Fundus photo: 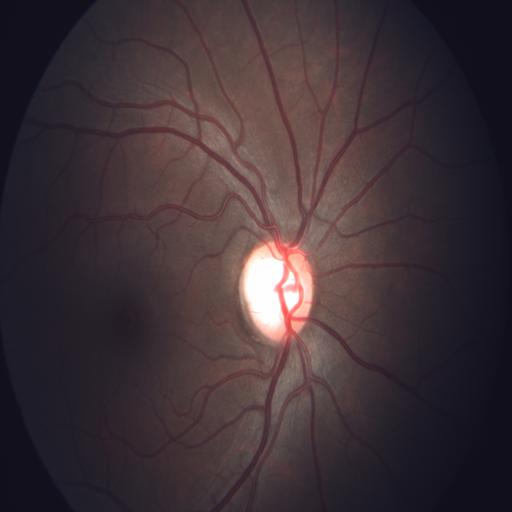
Diagnoses: optic disc pallor.